2212 by 1659 pixels. Retinal fundus photograph:
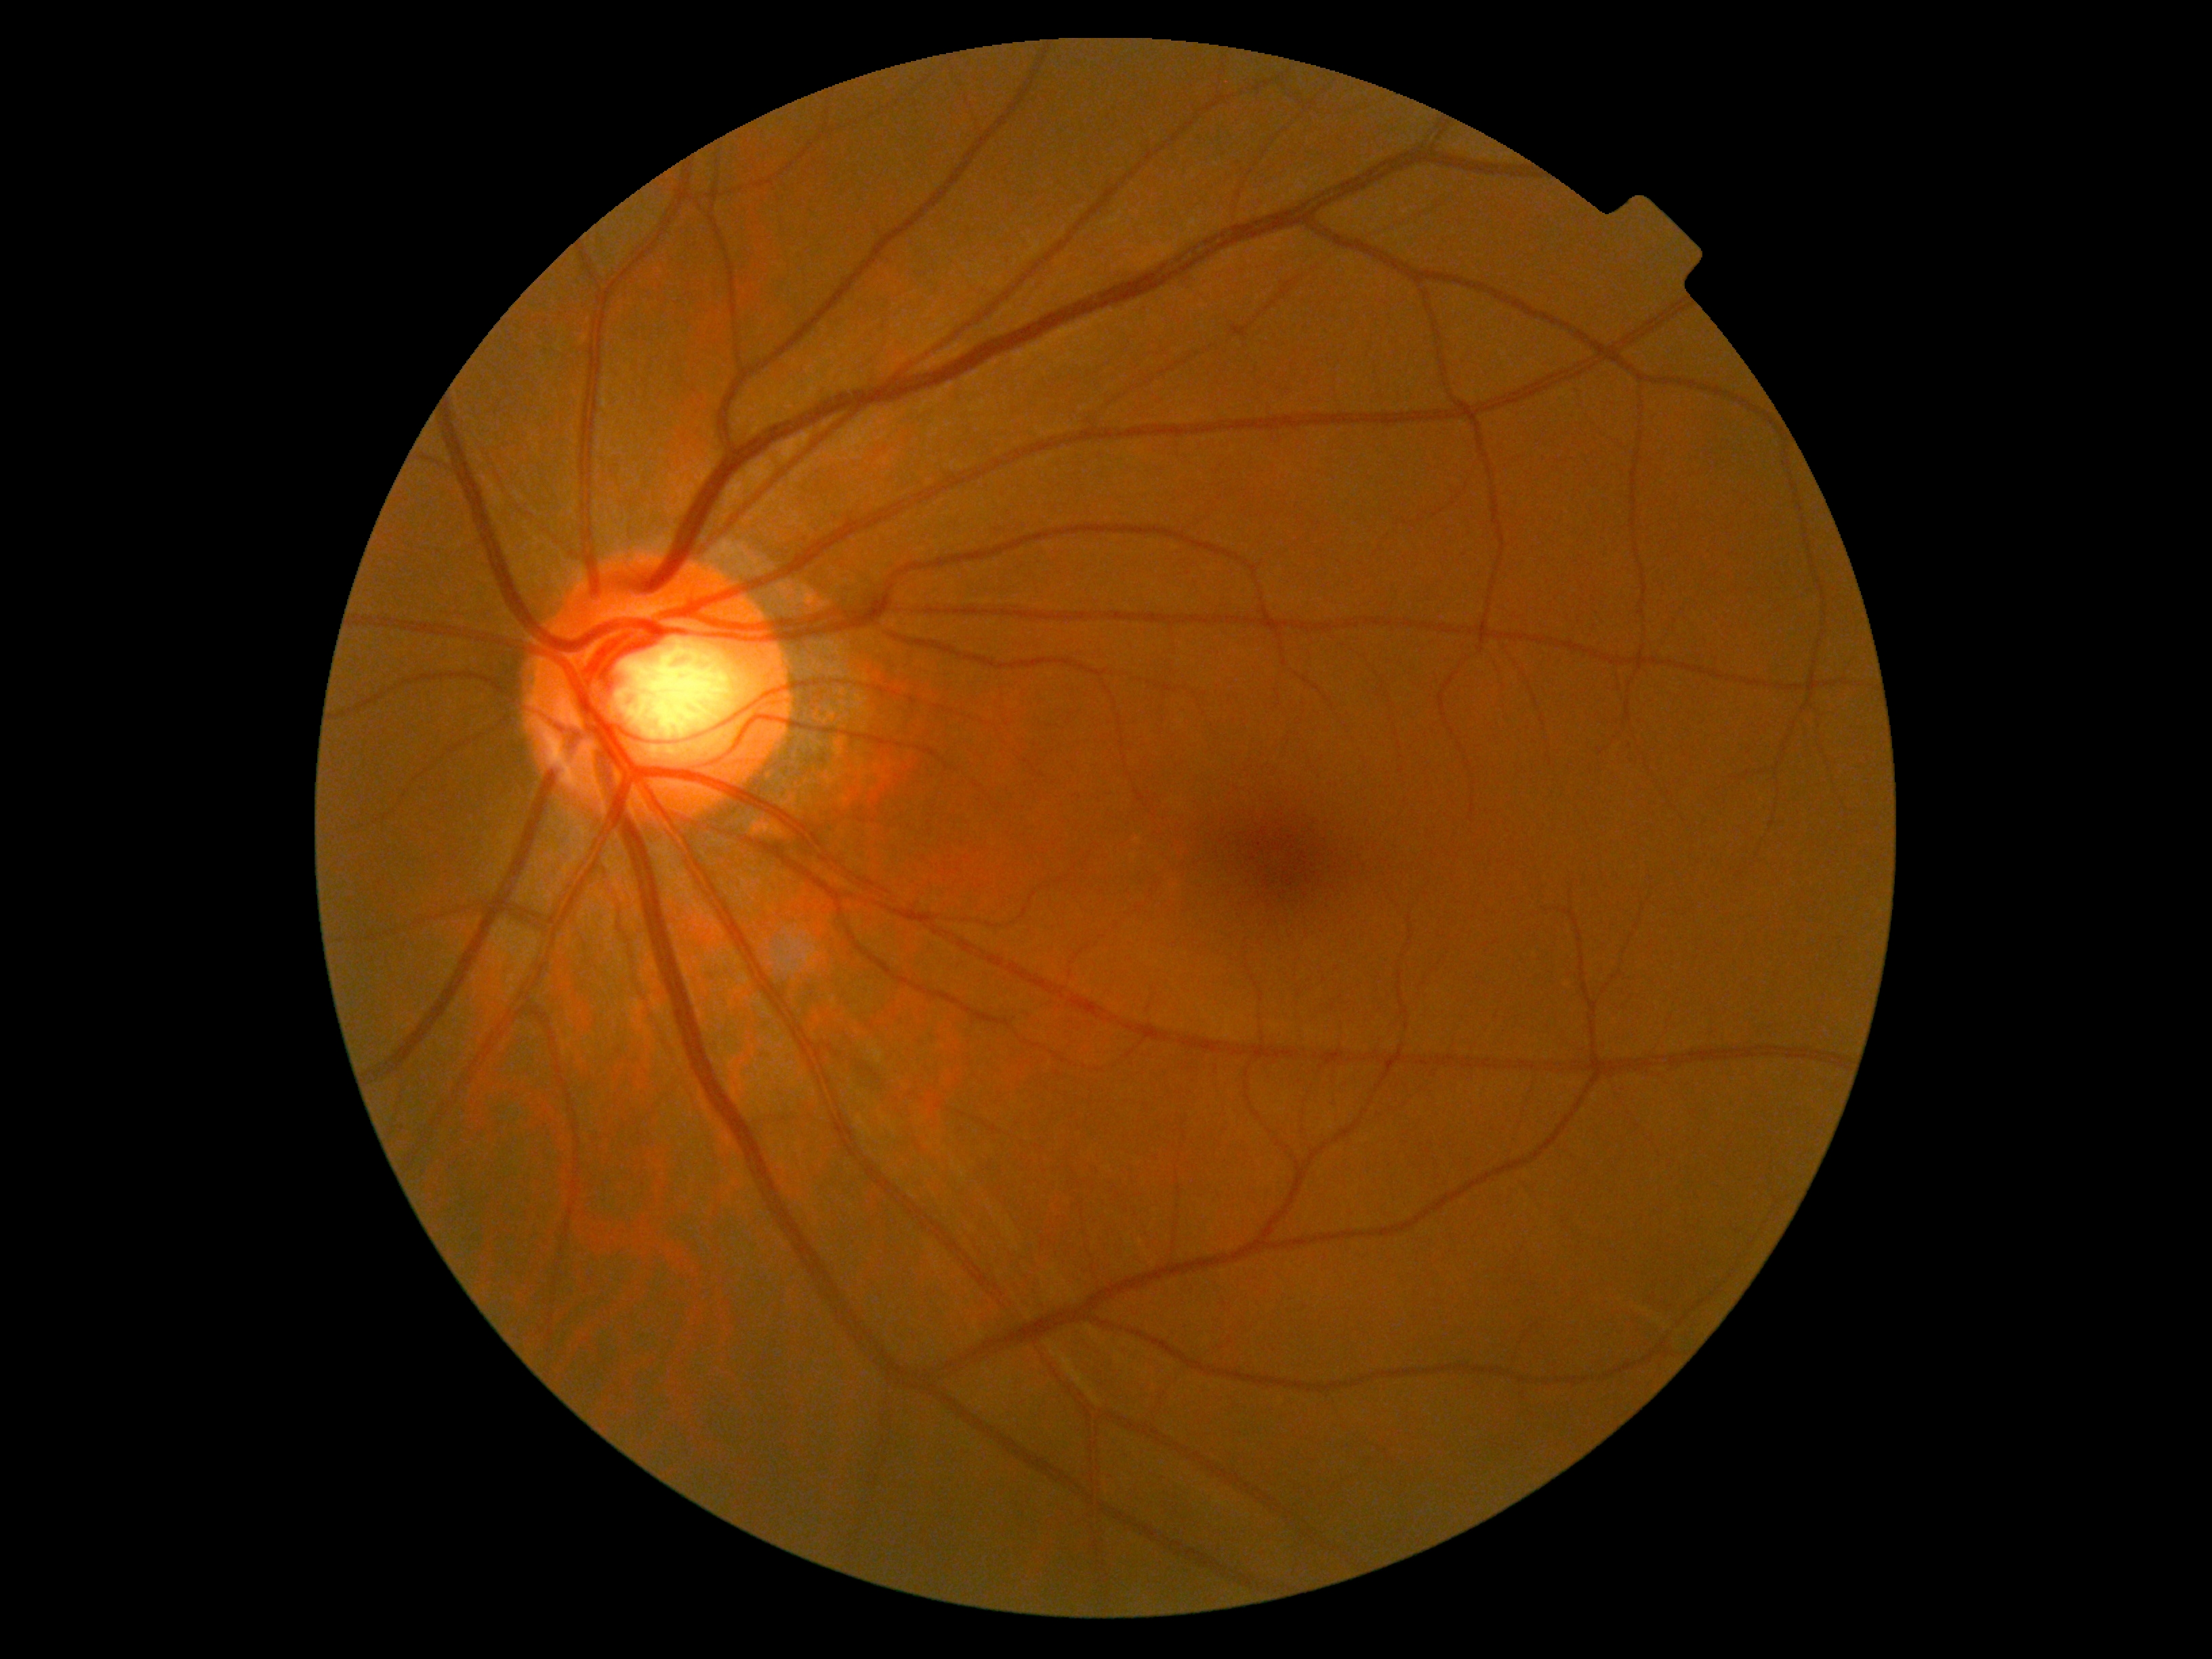 {"dr_grade": "grade 0 (no apparent retinopathy)"}